2346 by 1568 pixels · color fundus image · 45° field of view: 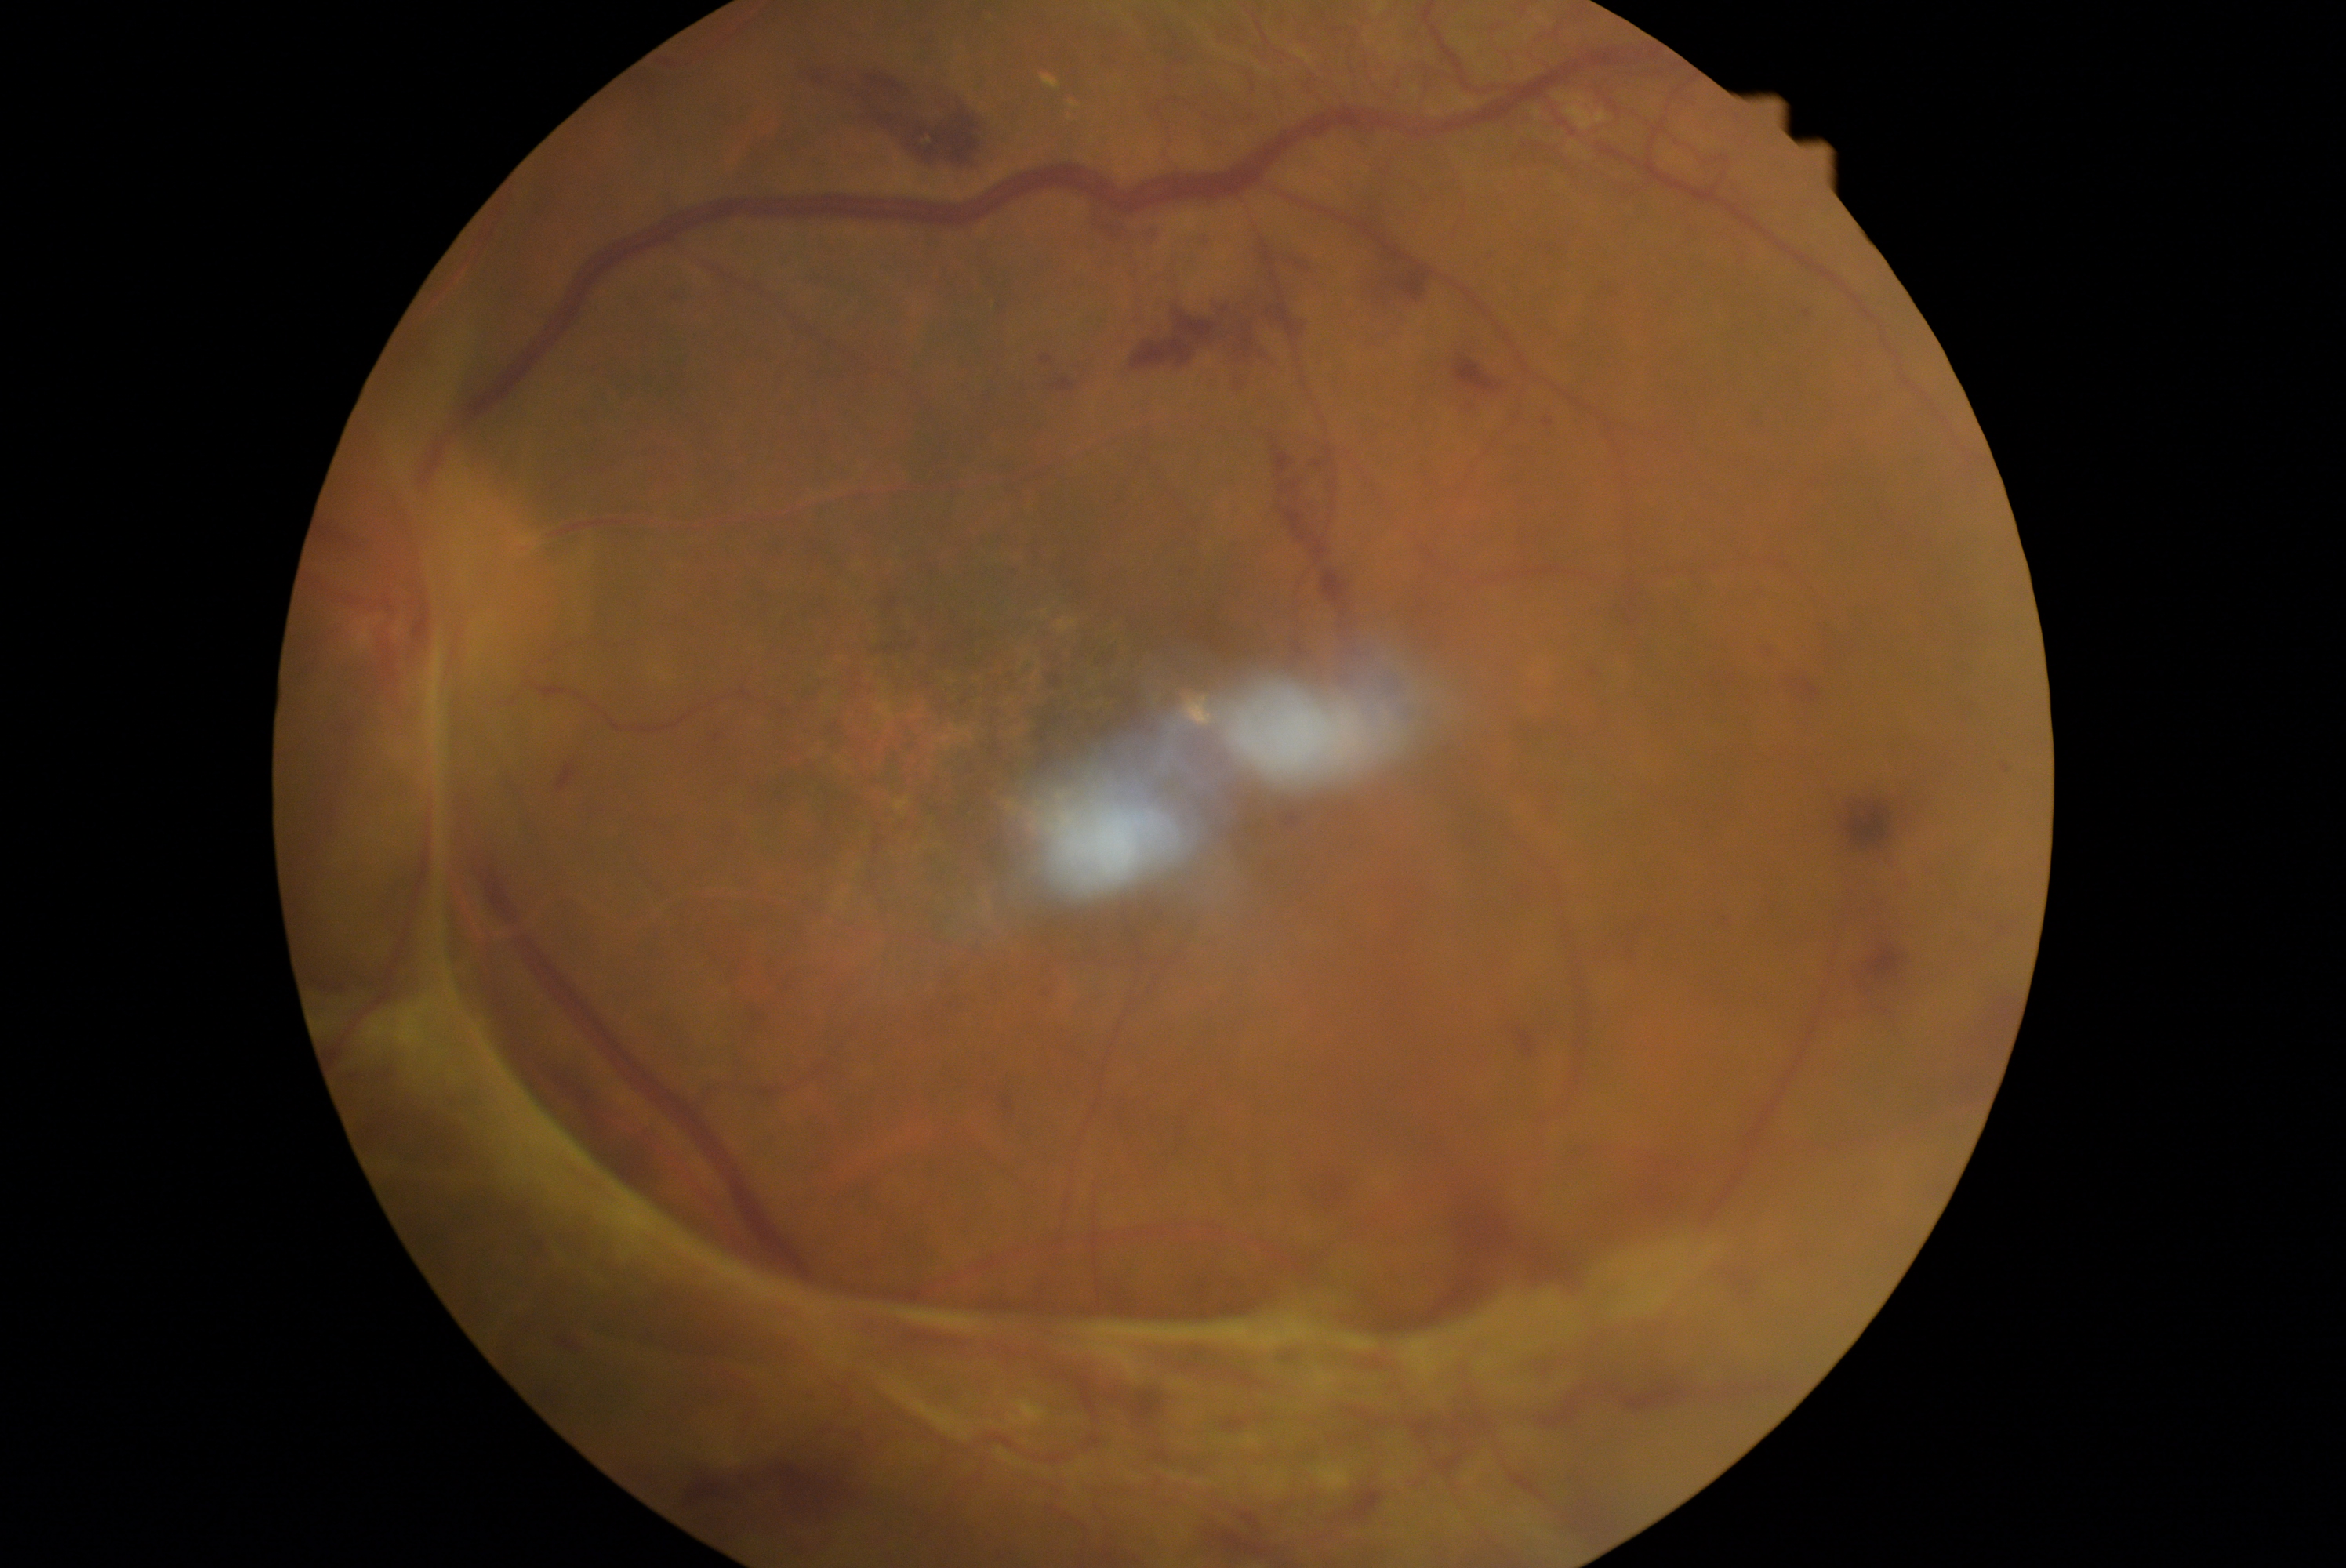
retinopathy grade: PDR (4).